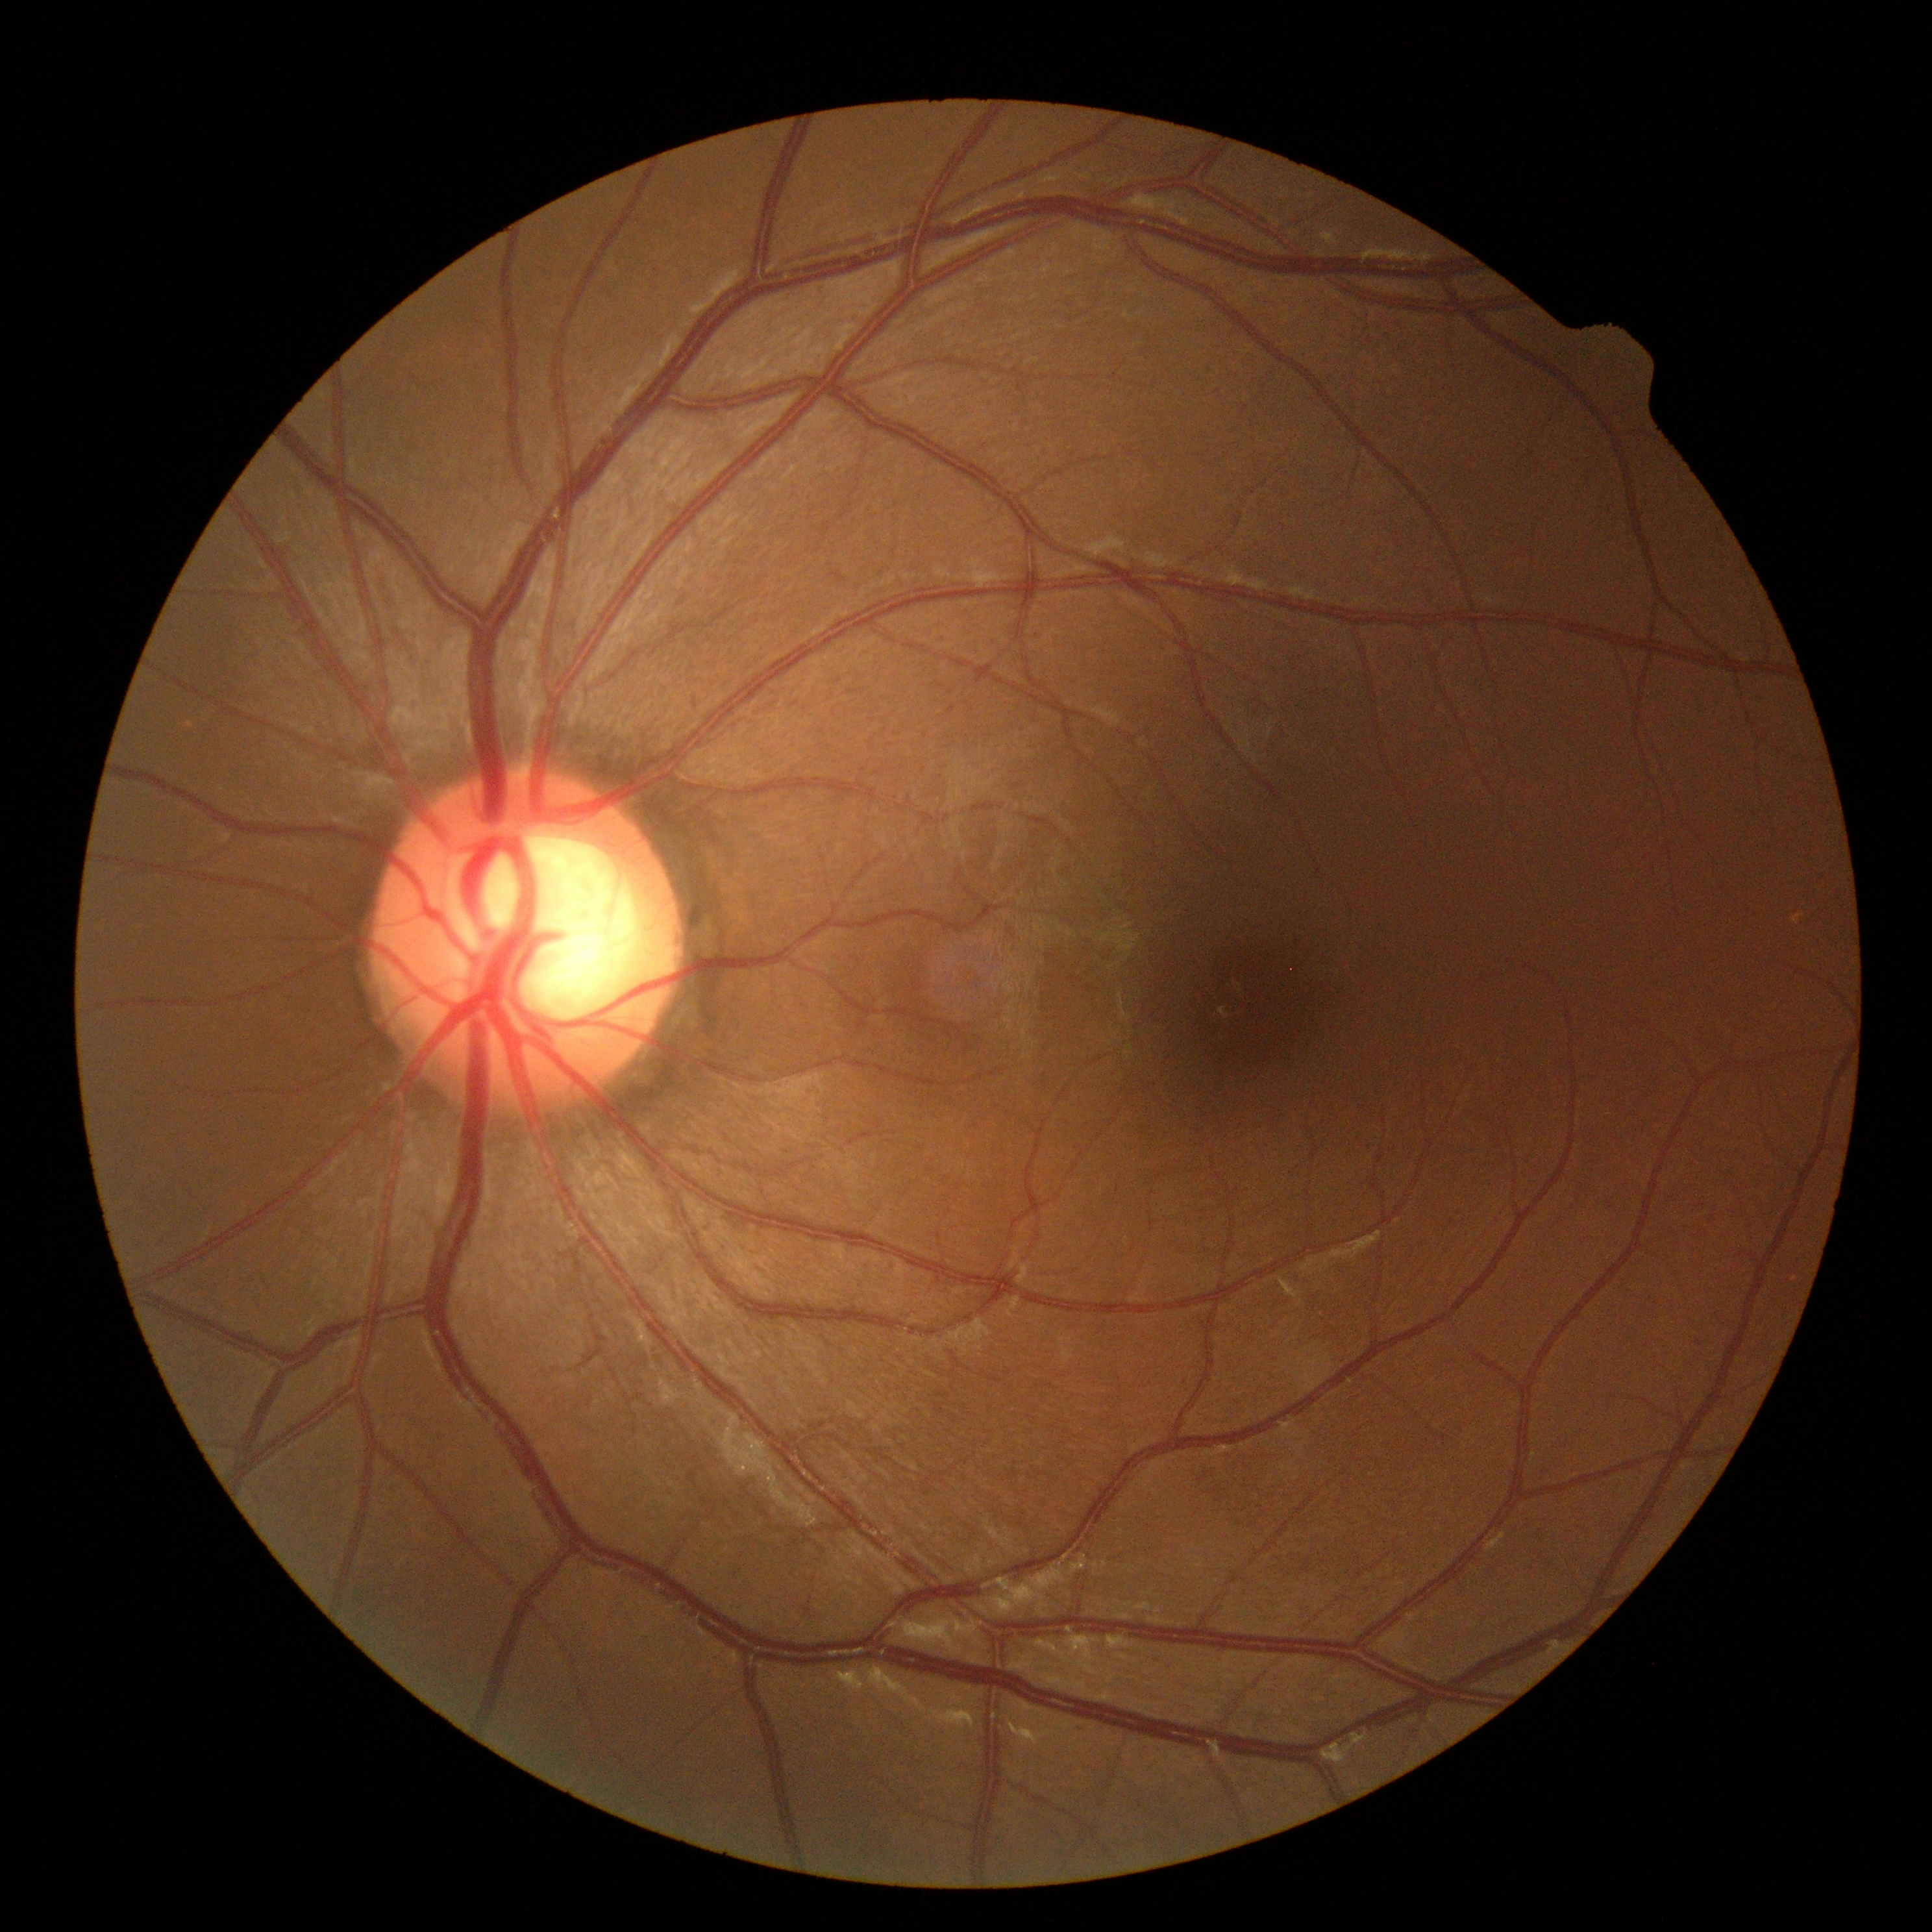 Diabetic retinopathy (DR) is 0 — no visible signs of diabetic retinopathy.